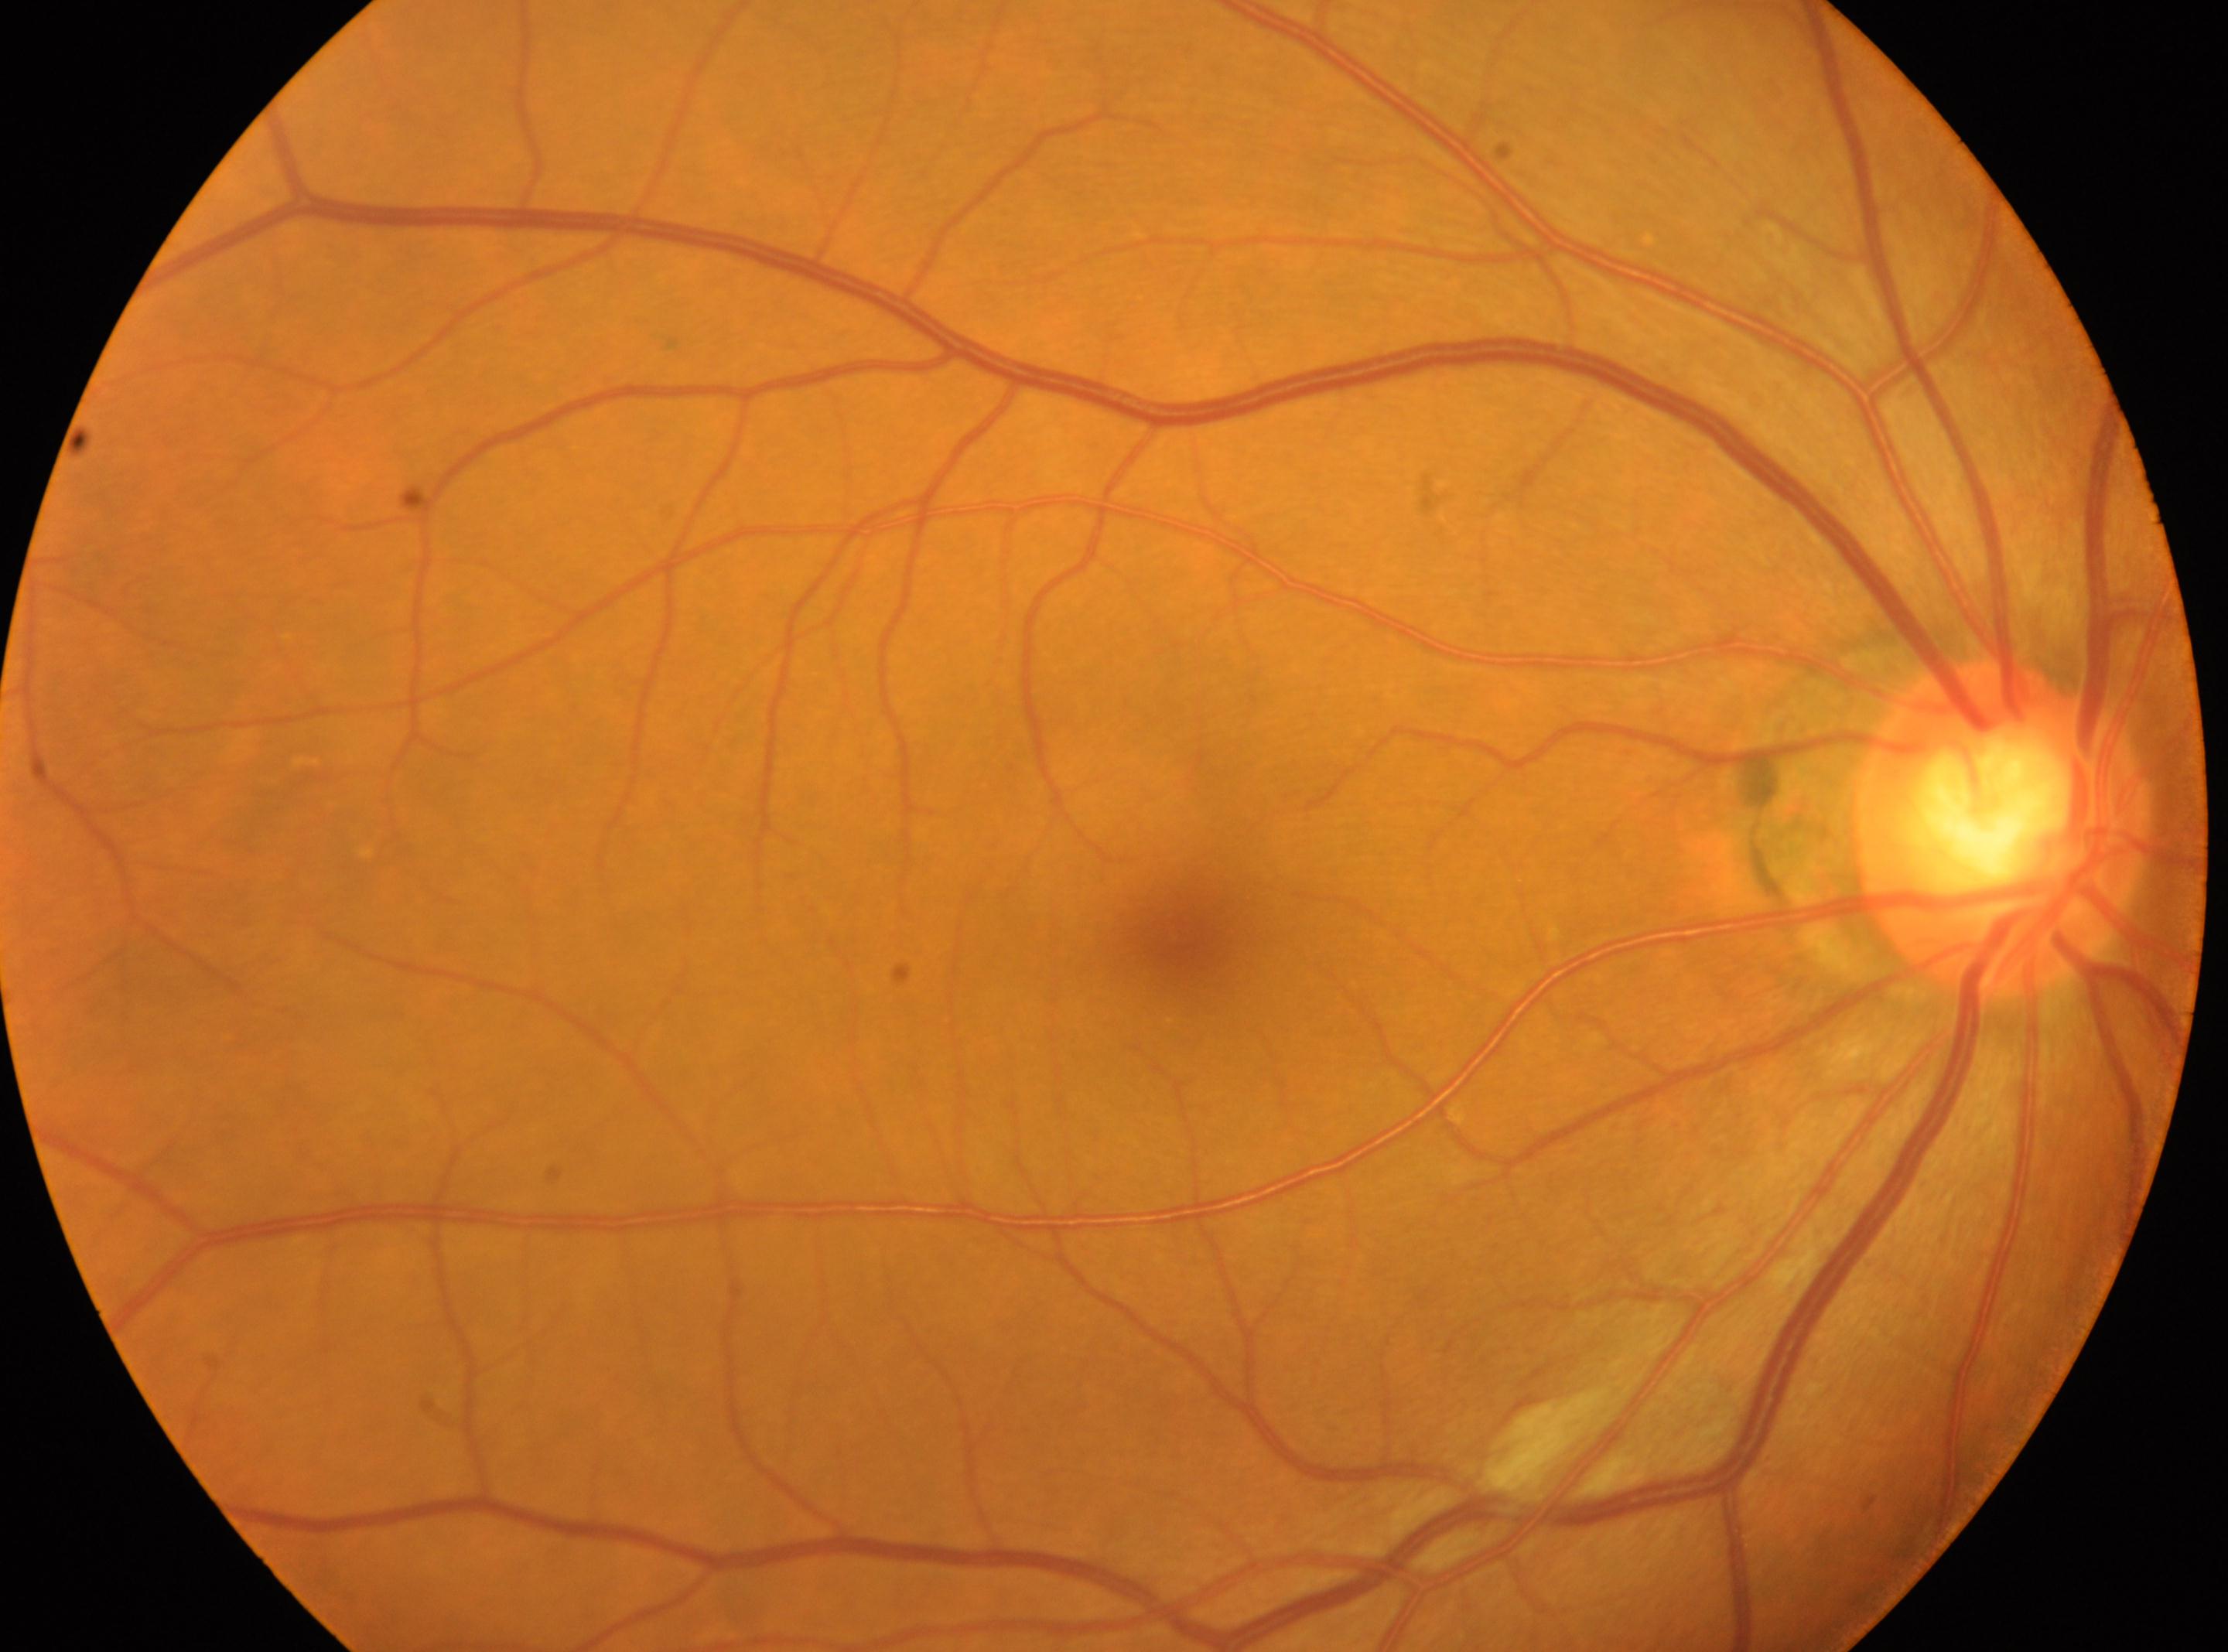

Diabetic retinopathy severity is 2. The macular center is at (x=1184, y=940). This is the right eye. The ONH is at (x=2005, y=828).